50-degree field of view: 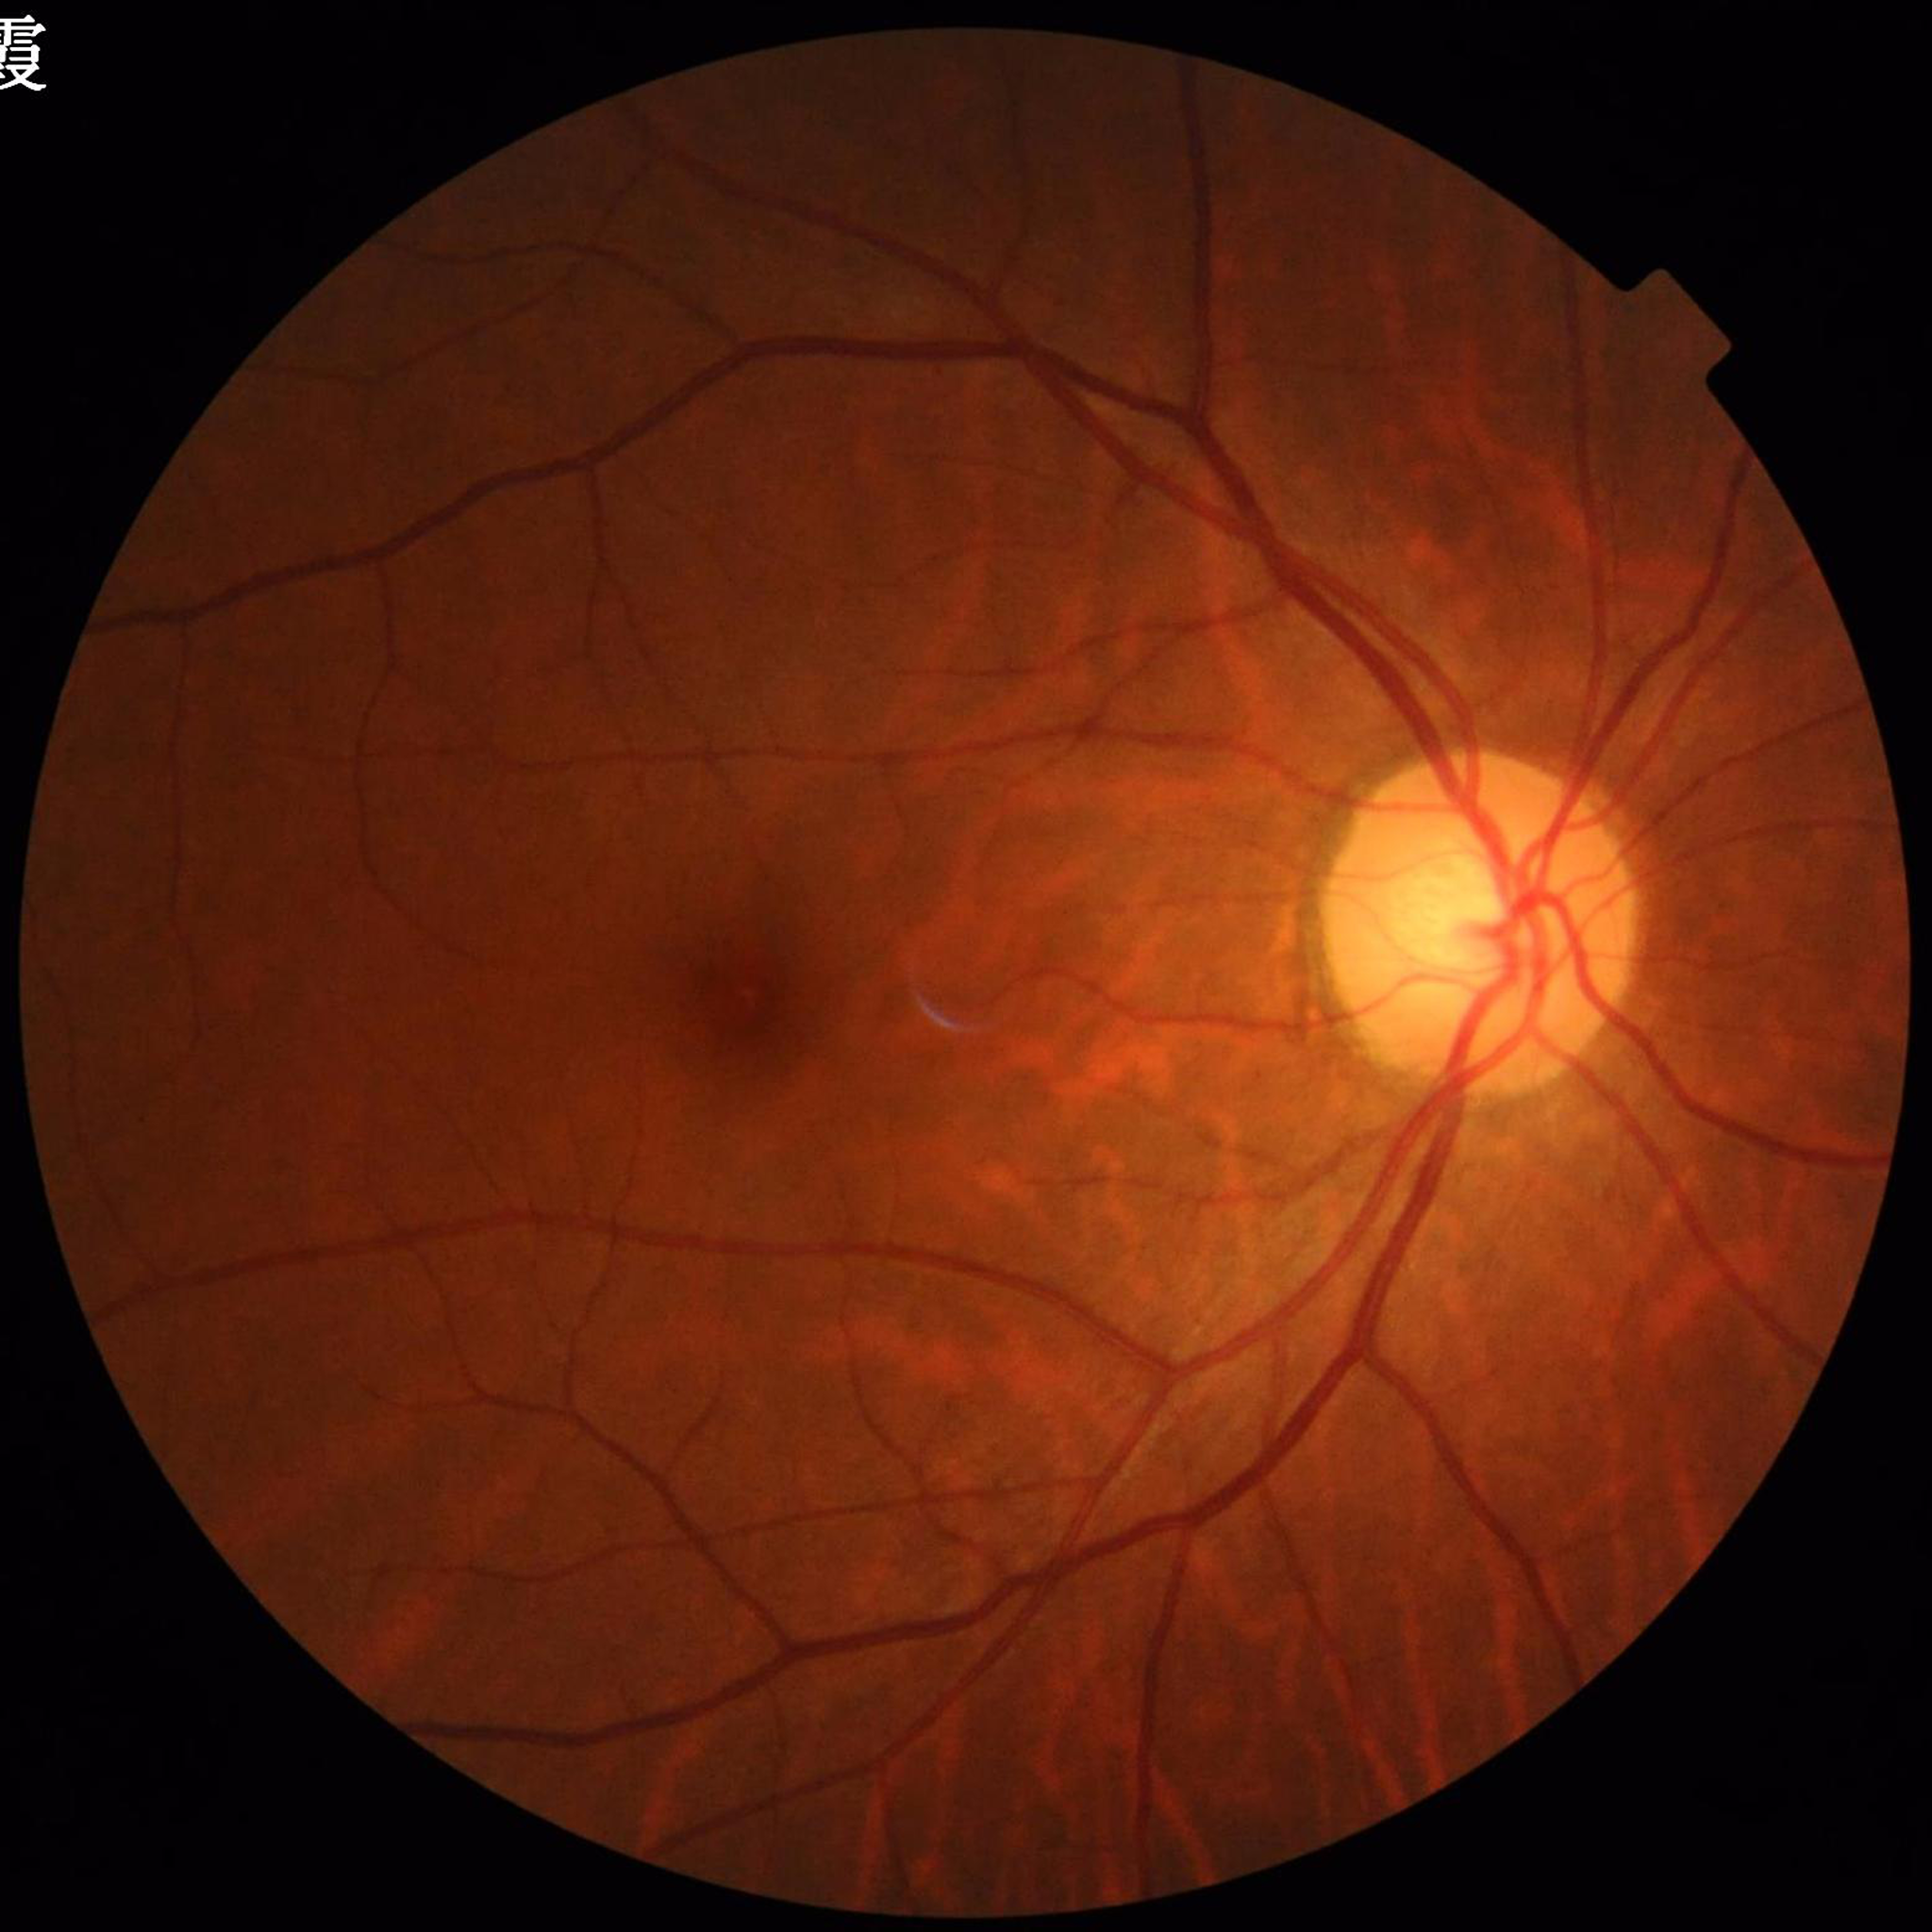

Clinical diagnosis = diabetic retinopathy (DR)